45-degree field of view · color fundus image · graded on the modified Davis scale.
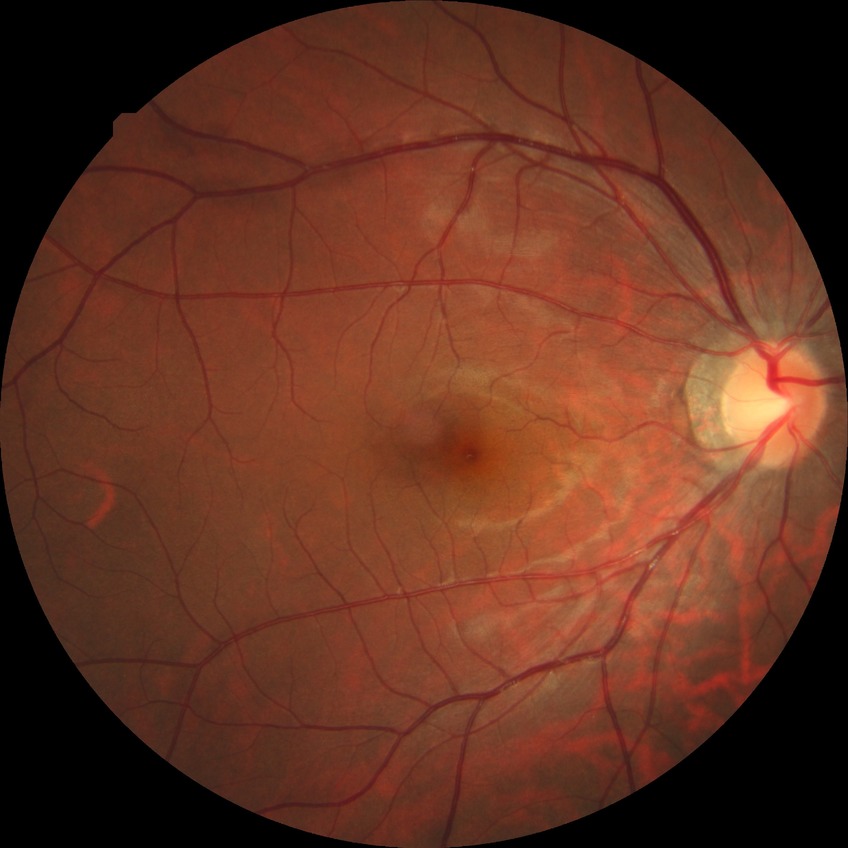 * retinopathy stage: no diabetic retinopathy